50-degree field of view; 2228 by 1652 pixels; fundus photo; posterior pole view.
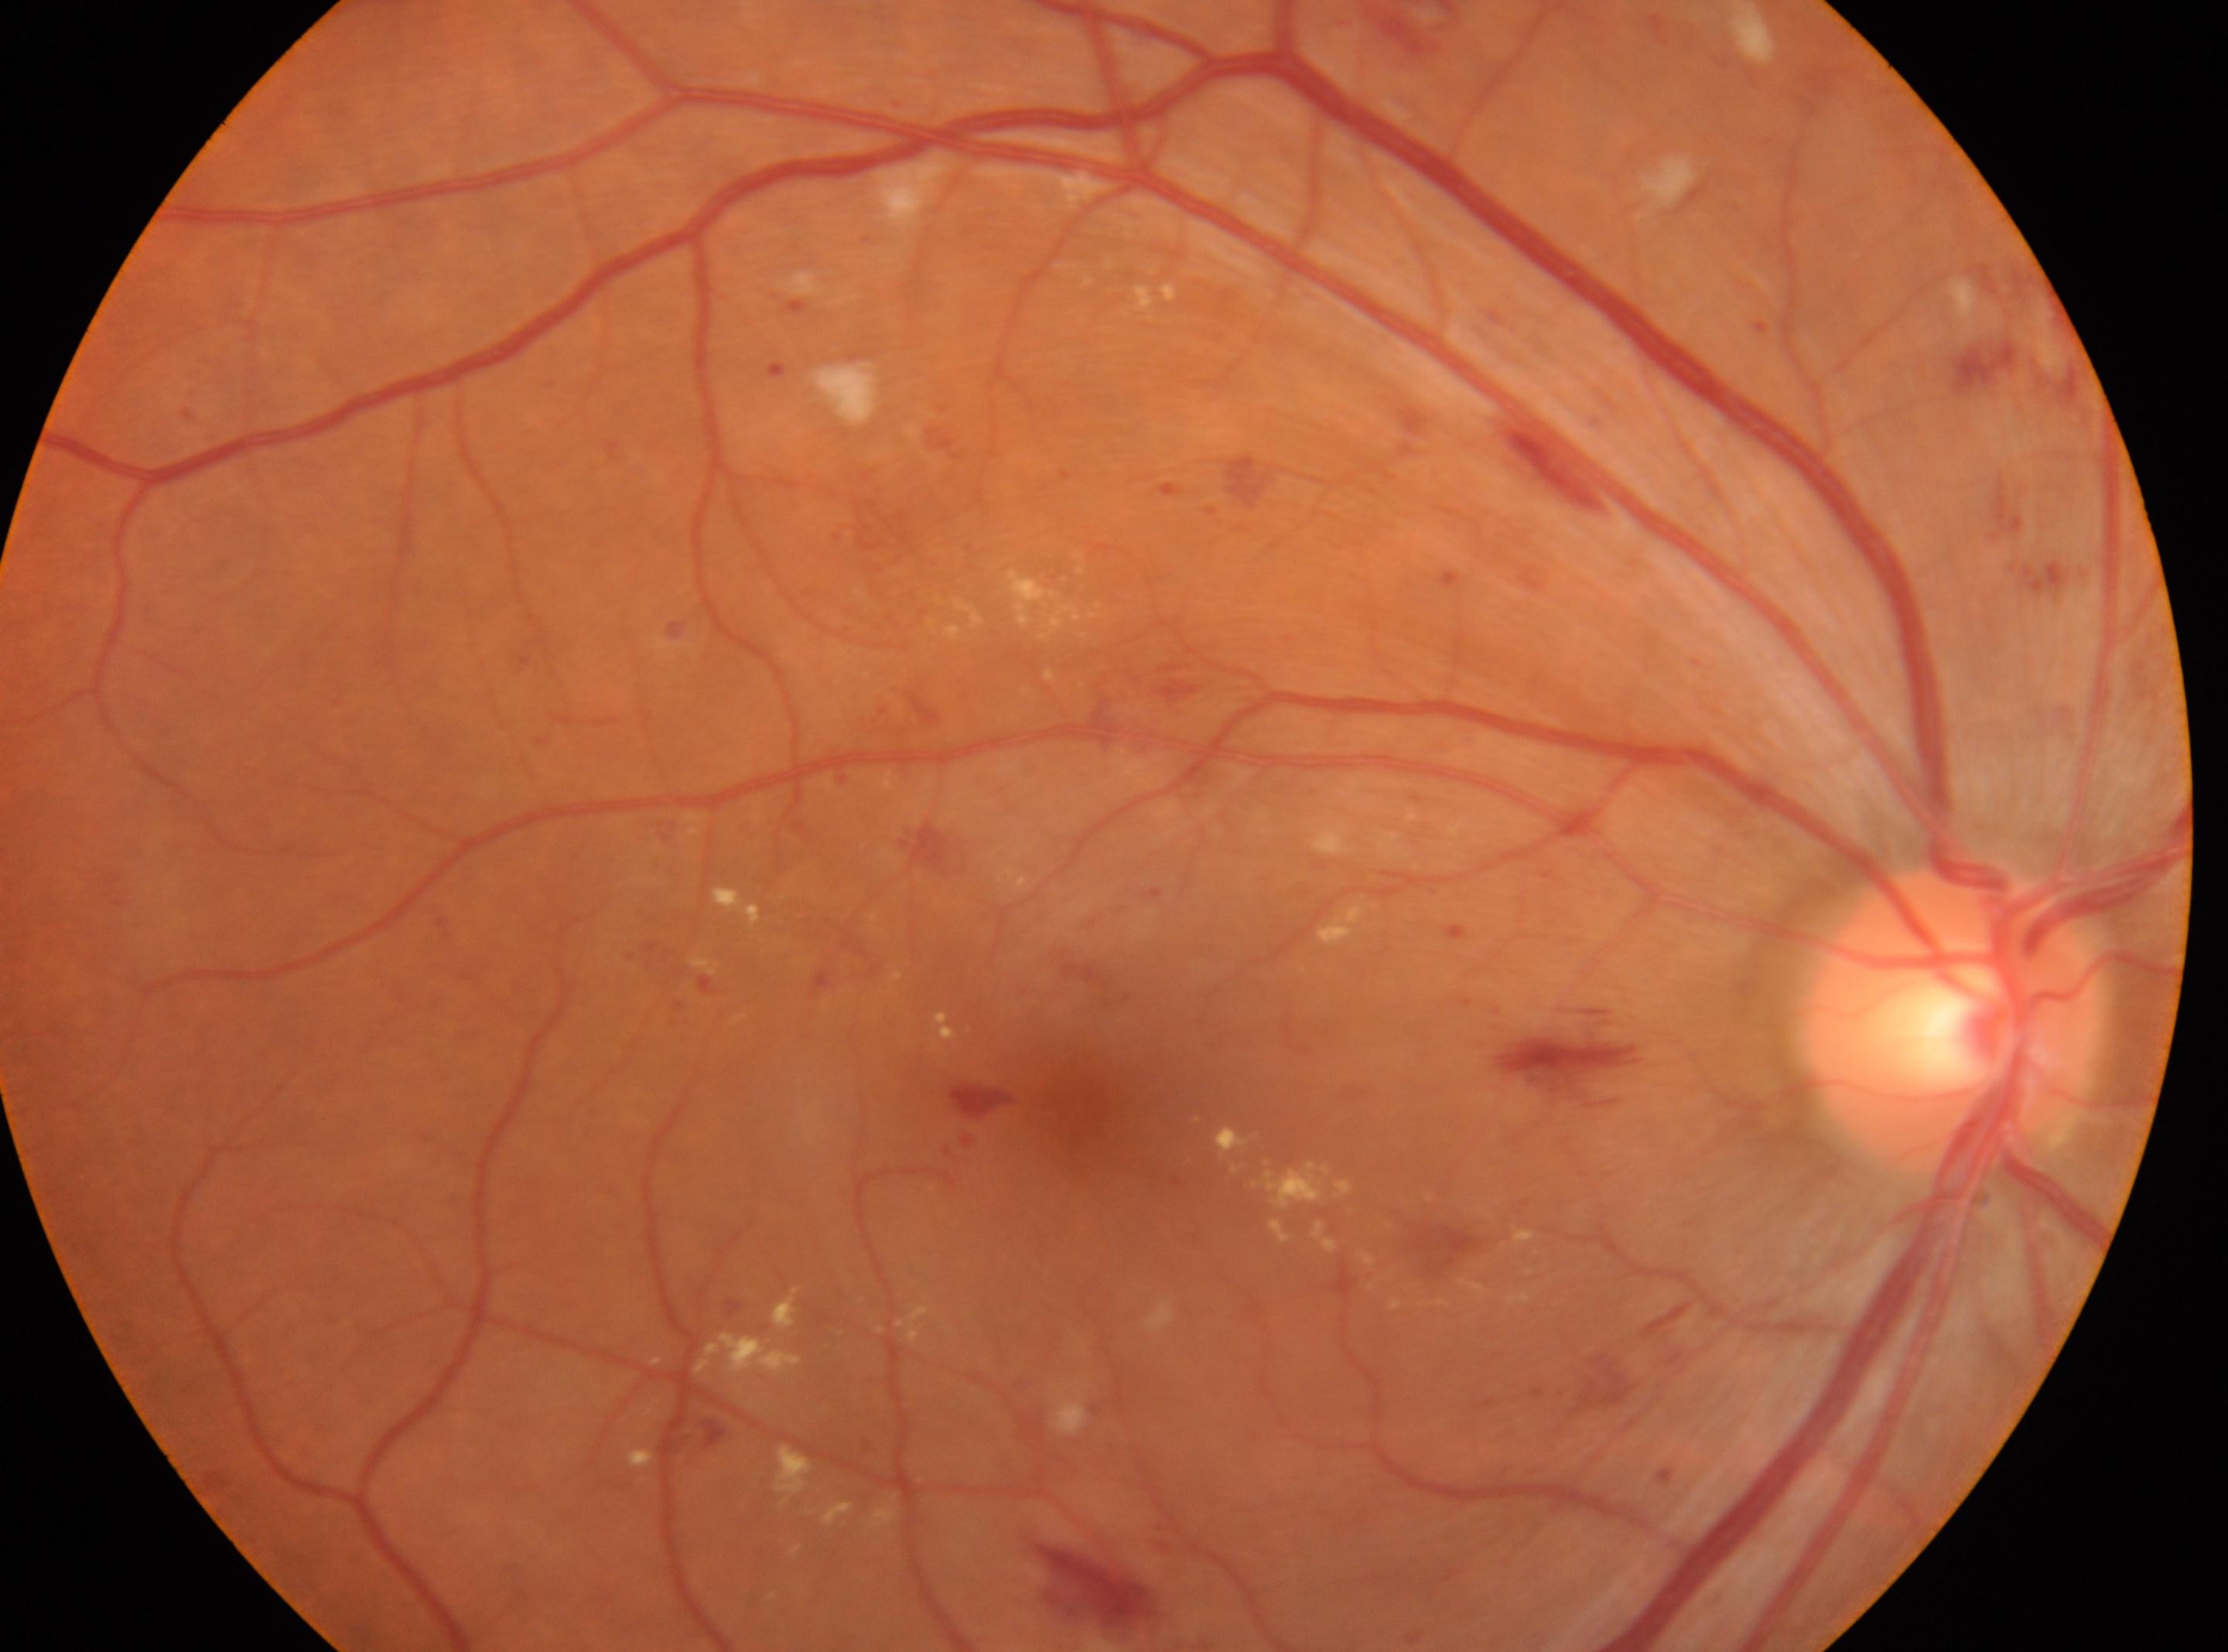
foveal center: 1083, 1097; the optic disc: 1950, 1013; laterality: right; diabetic retinopathy (DR): severe NPDR (grade 3).